Wide-field contact fundus photograph of an infant; captured with the Clarity RetCam 3 (130° field of view)
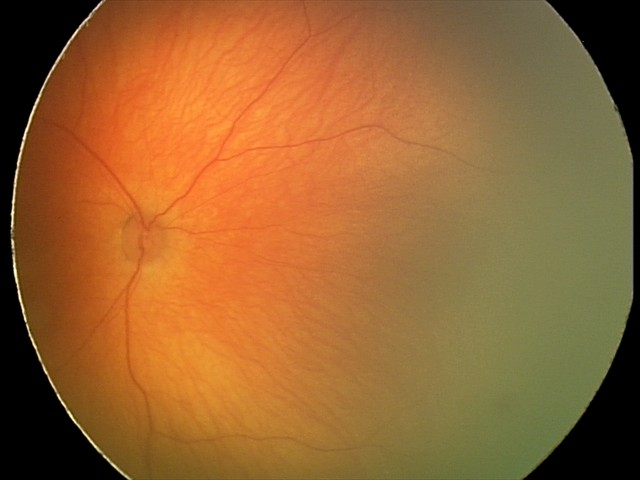
Physiological retinal appearance for postconceptual age.